FOV: 45 degrees · image size 848x848 · nonmydriatic · acquired with a NIDEK AFC-230:
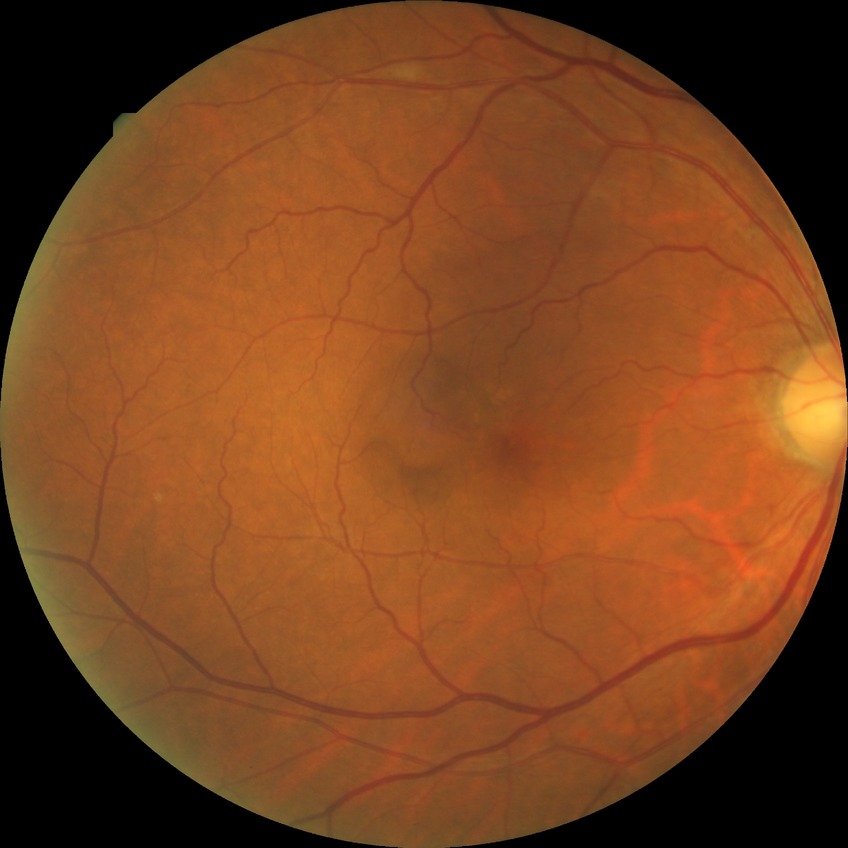

retinopathy grade: no diabetic retinopathy.